1536 by 1152 pixels — 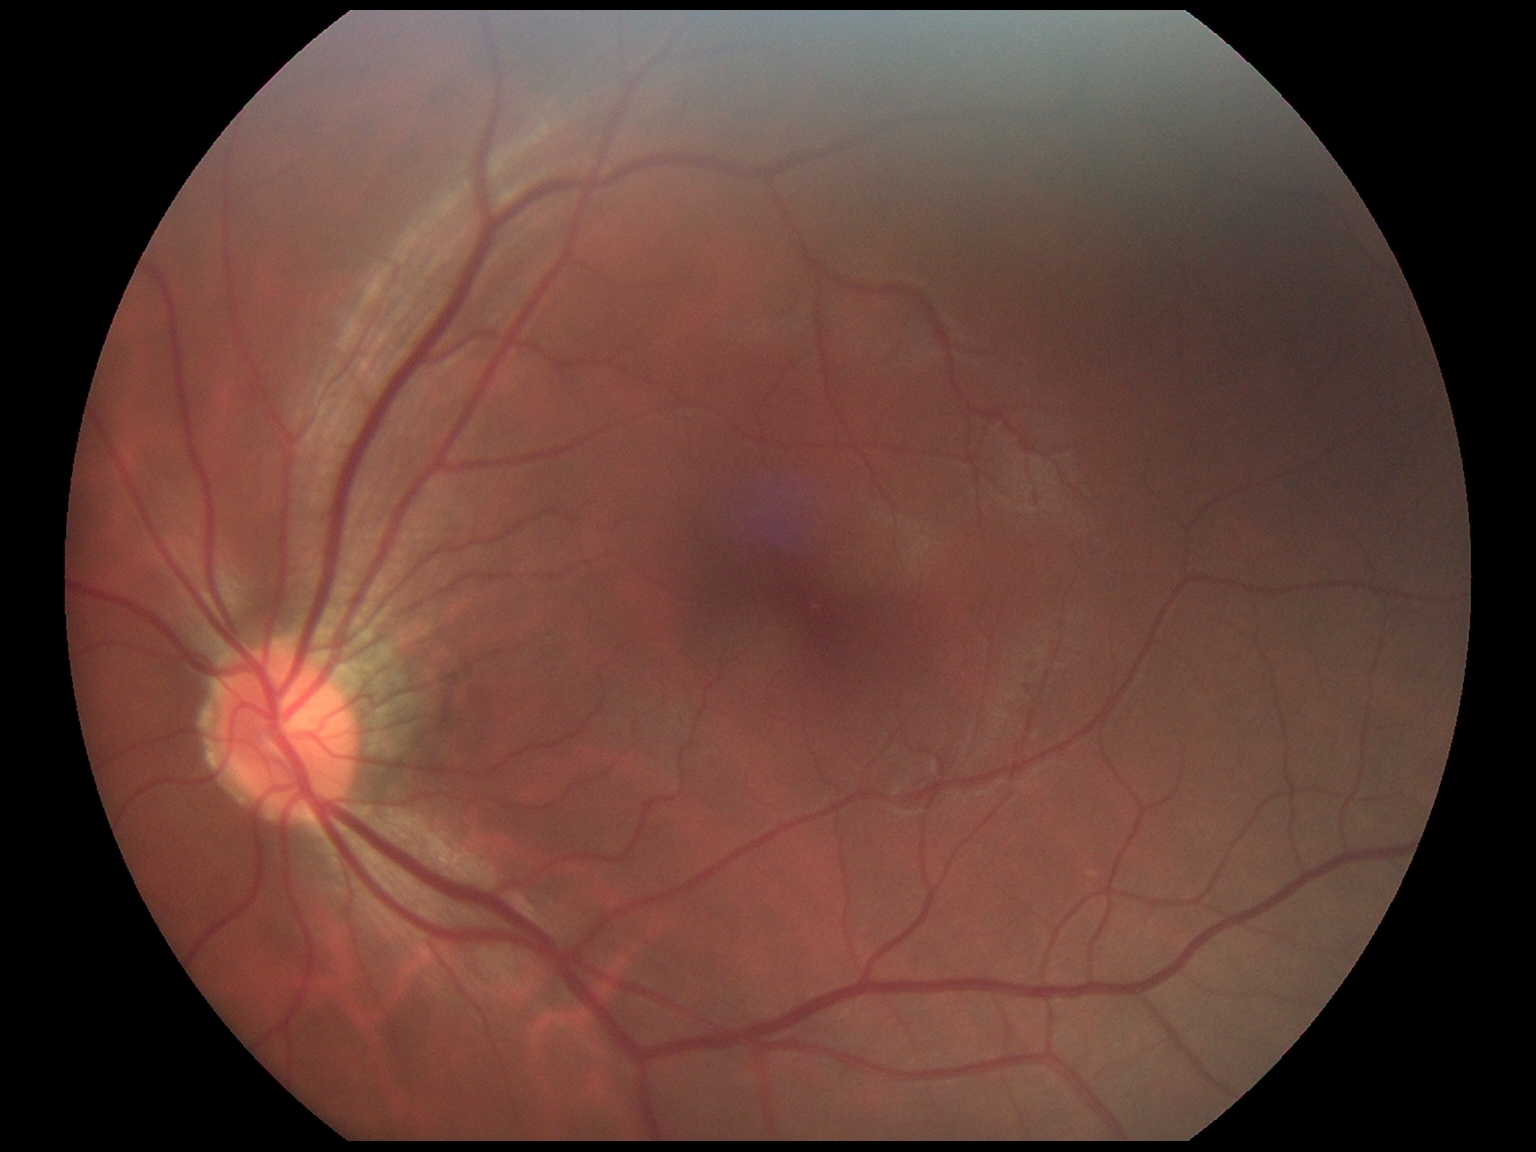
DR stage: 0.
No diabetic retinal disease findings.